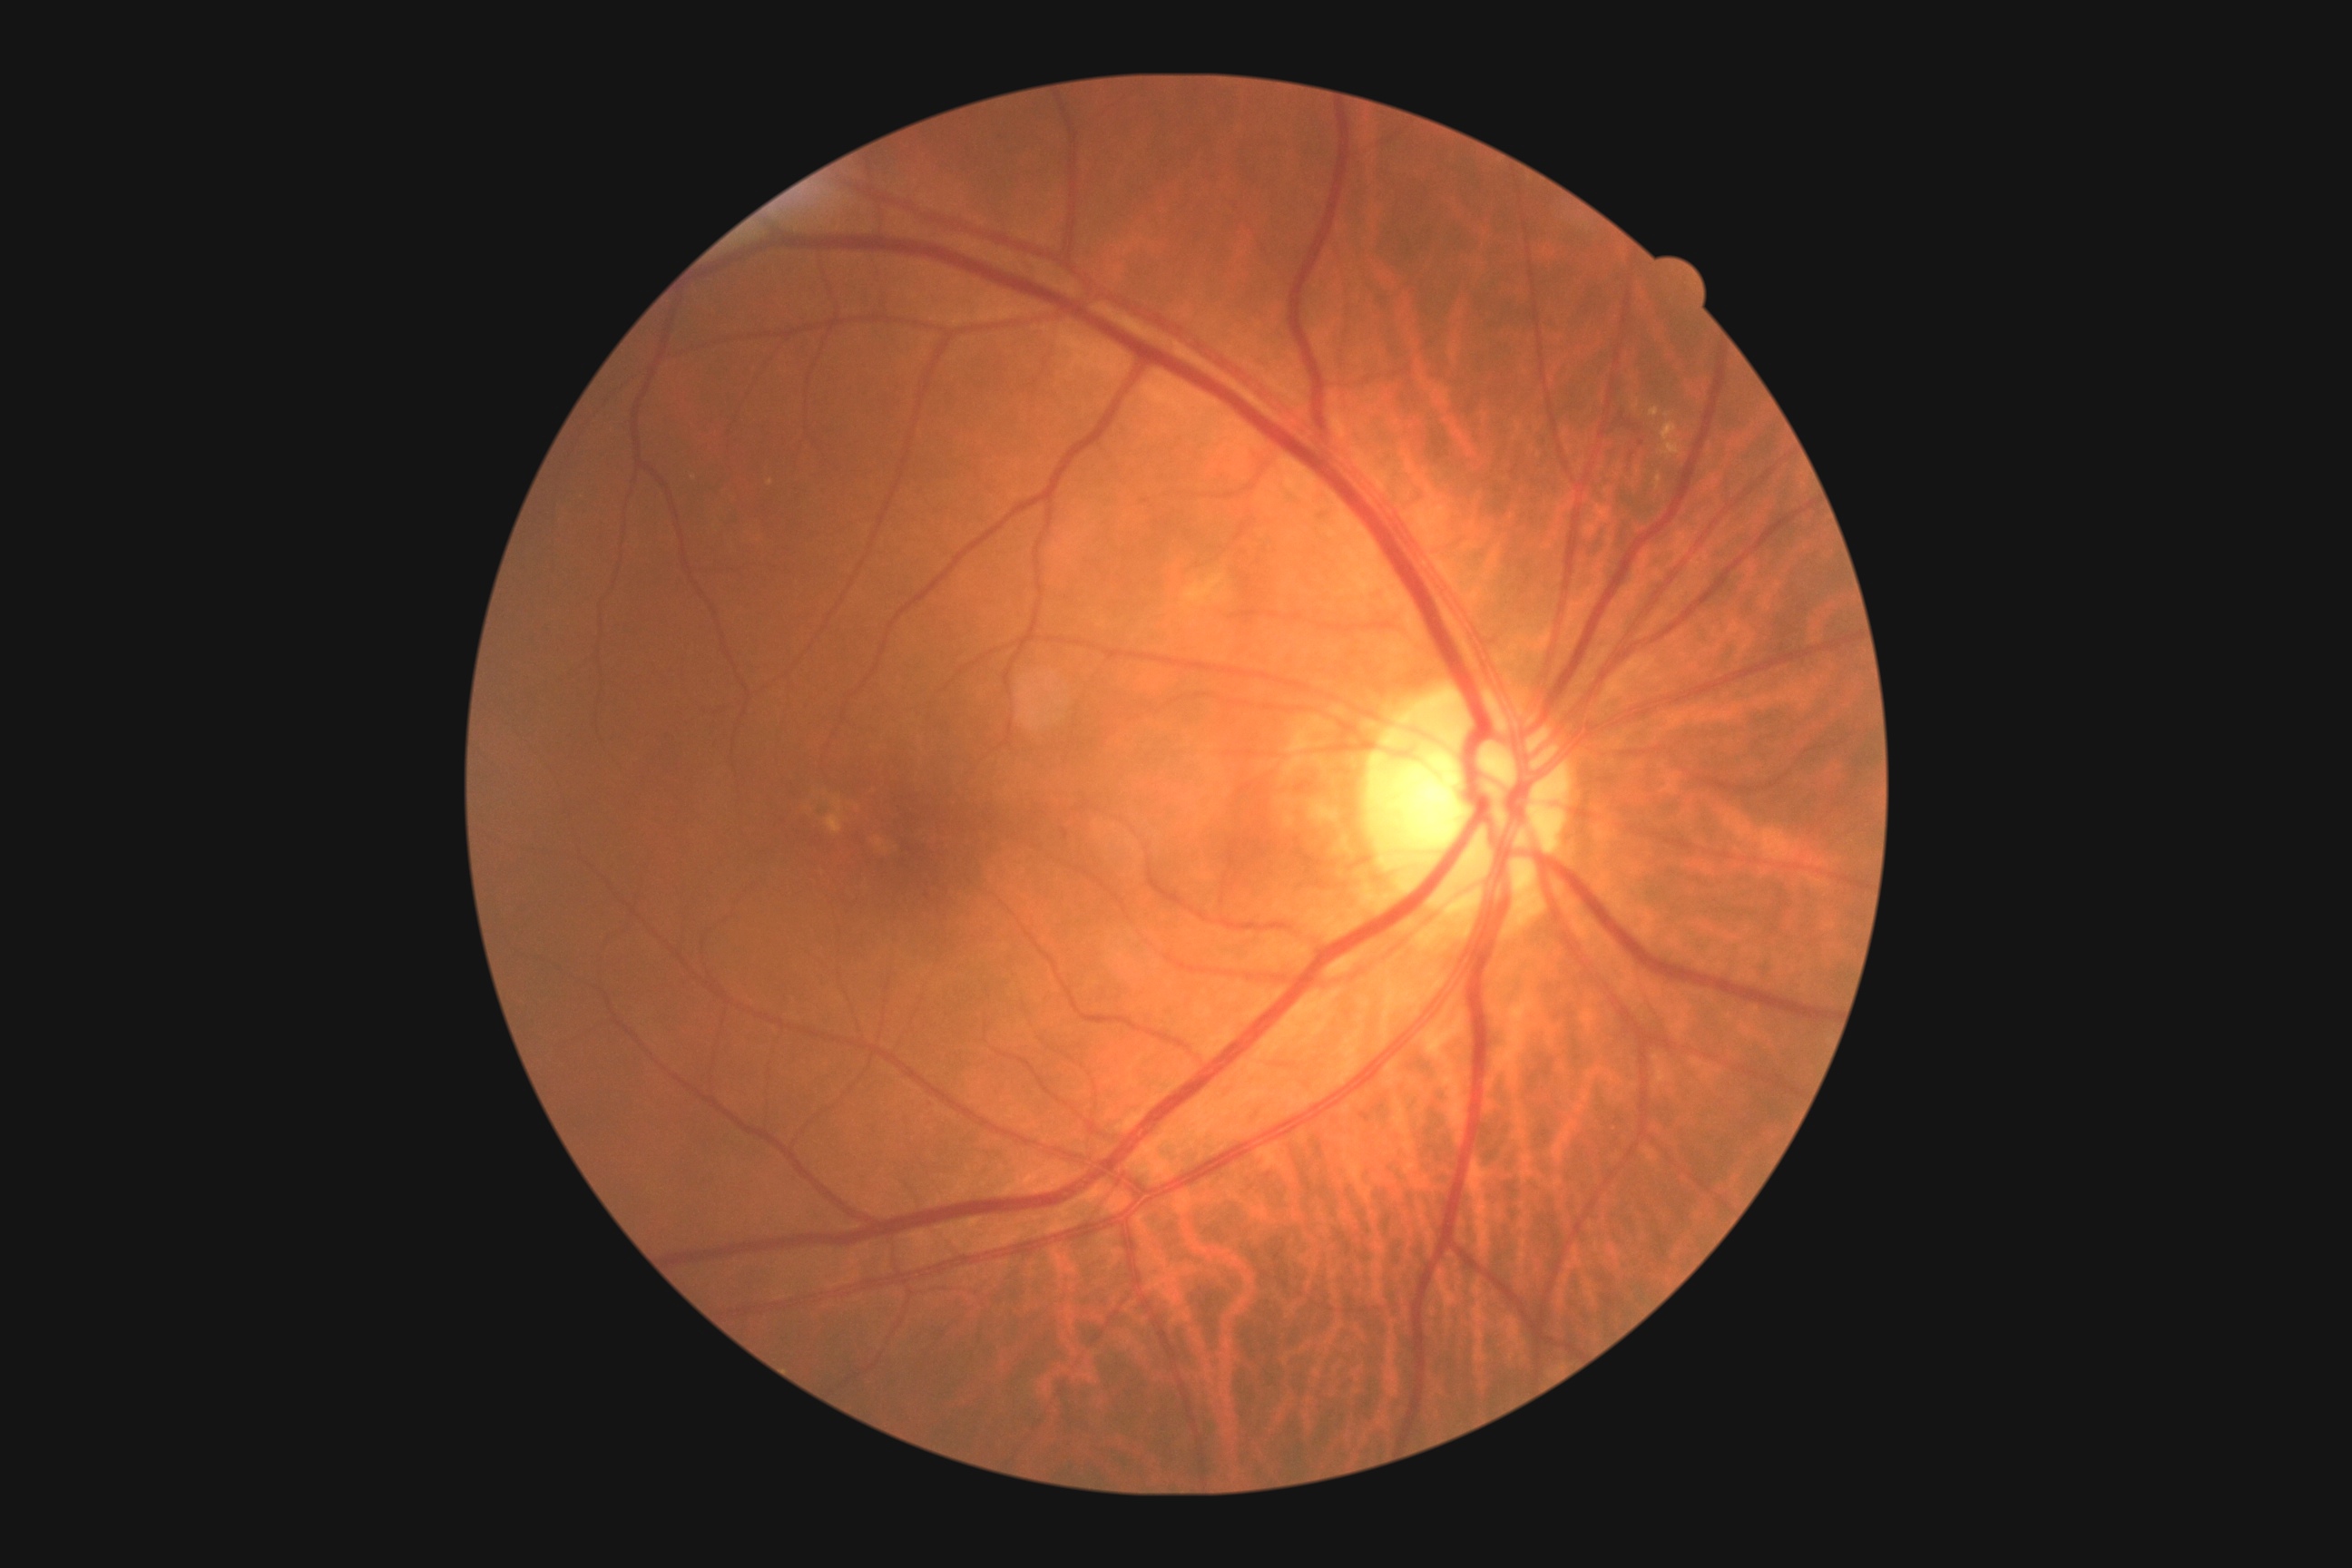 DR class: non-proliferative diabetic retinopathy. DR grade: moderate non-proliferative diabetic retinopathy (2) — more than just microaneurysms but less than severe NPDR.